Color fundus image — 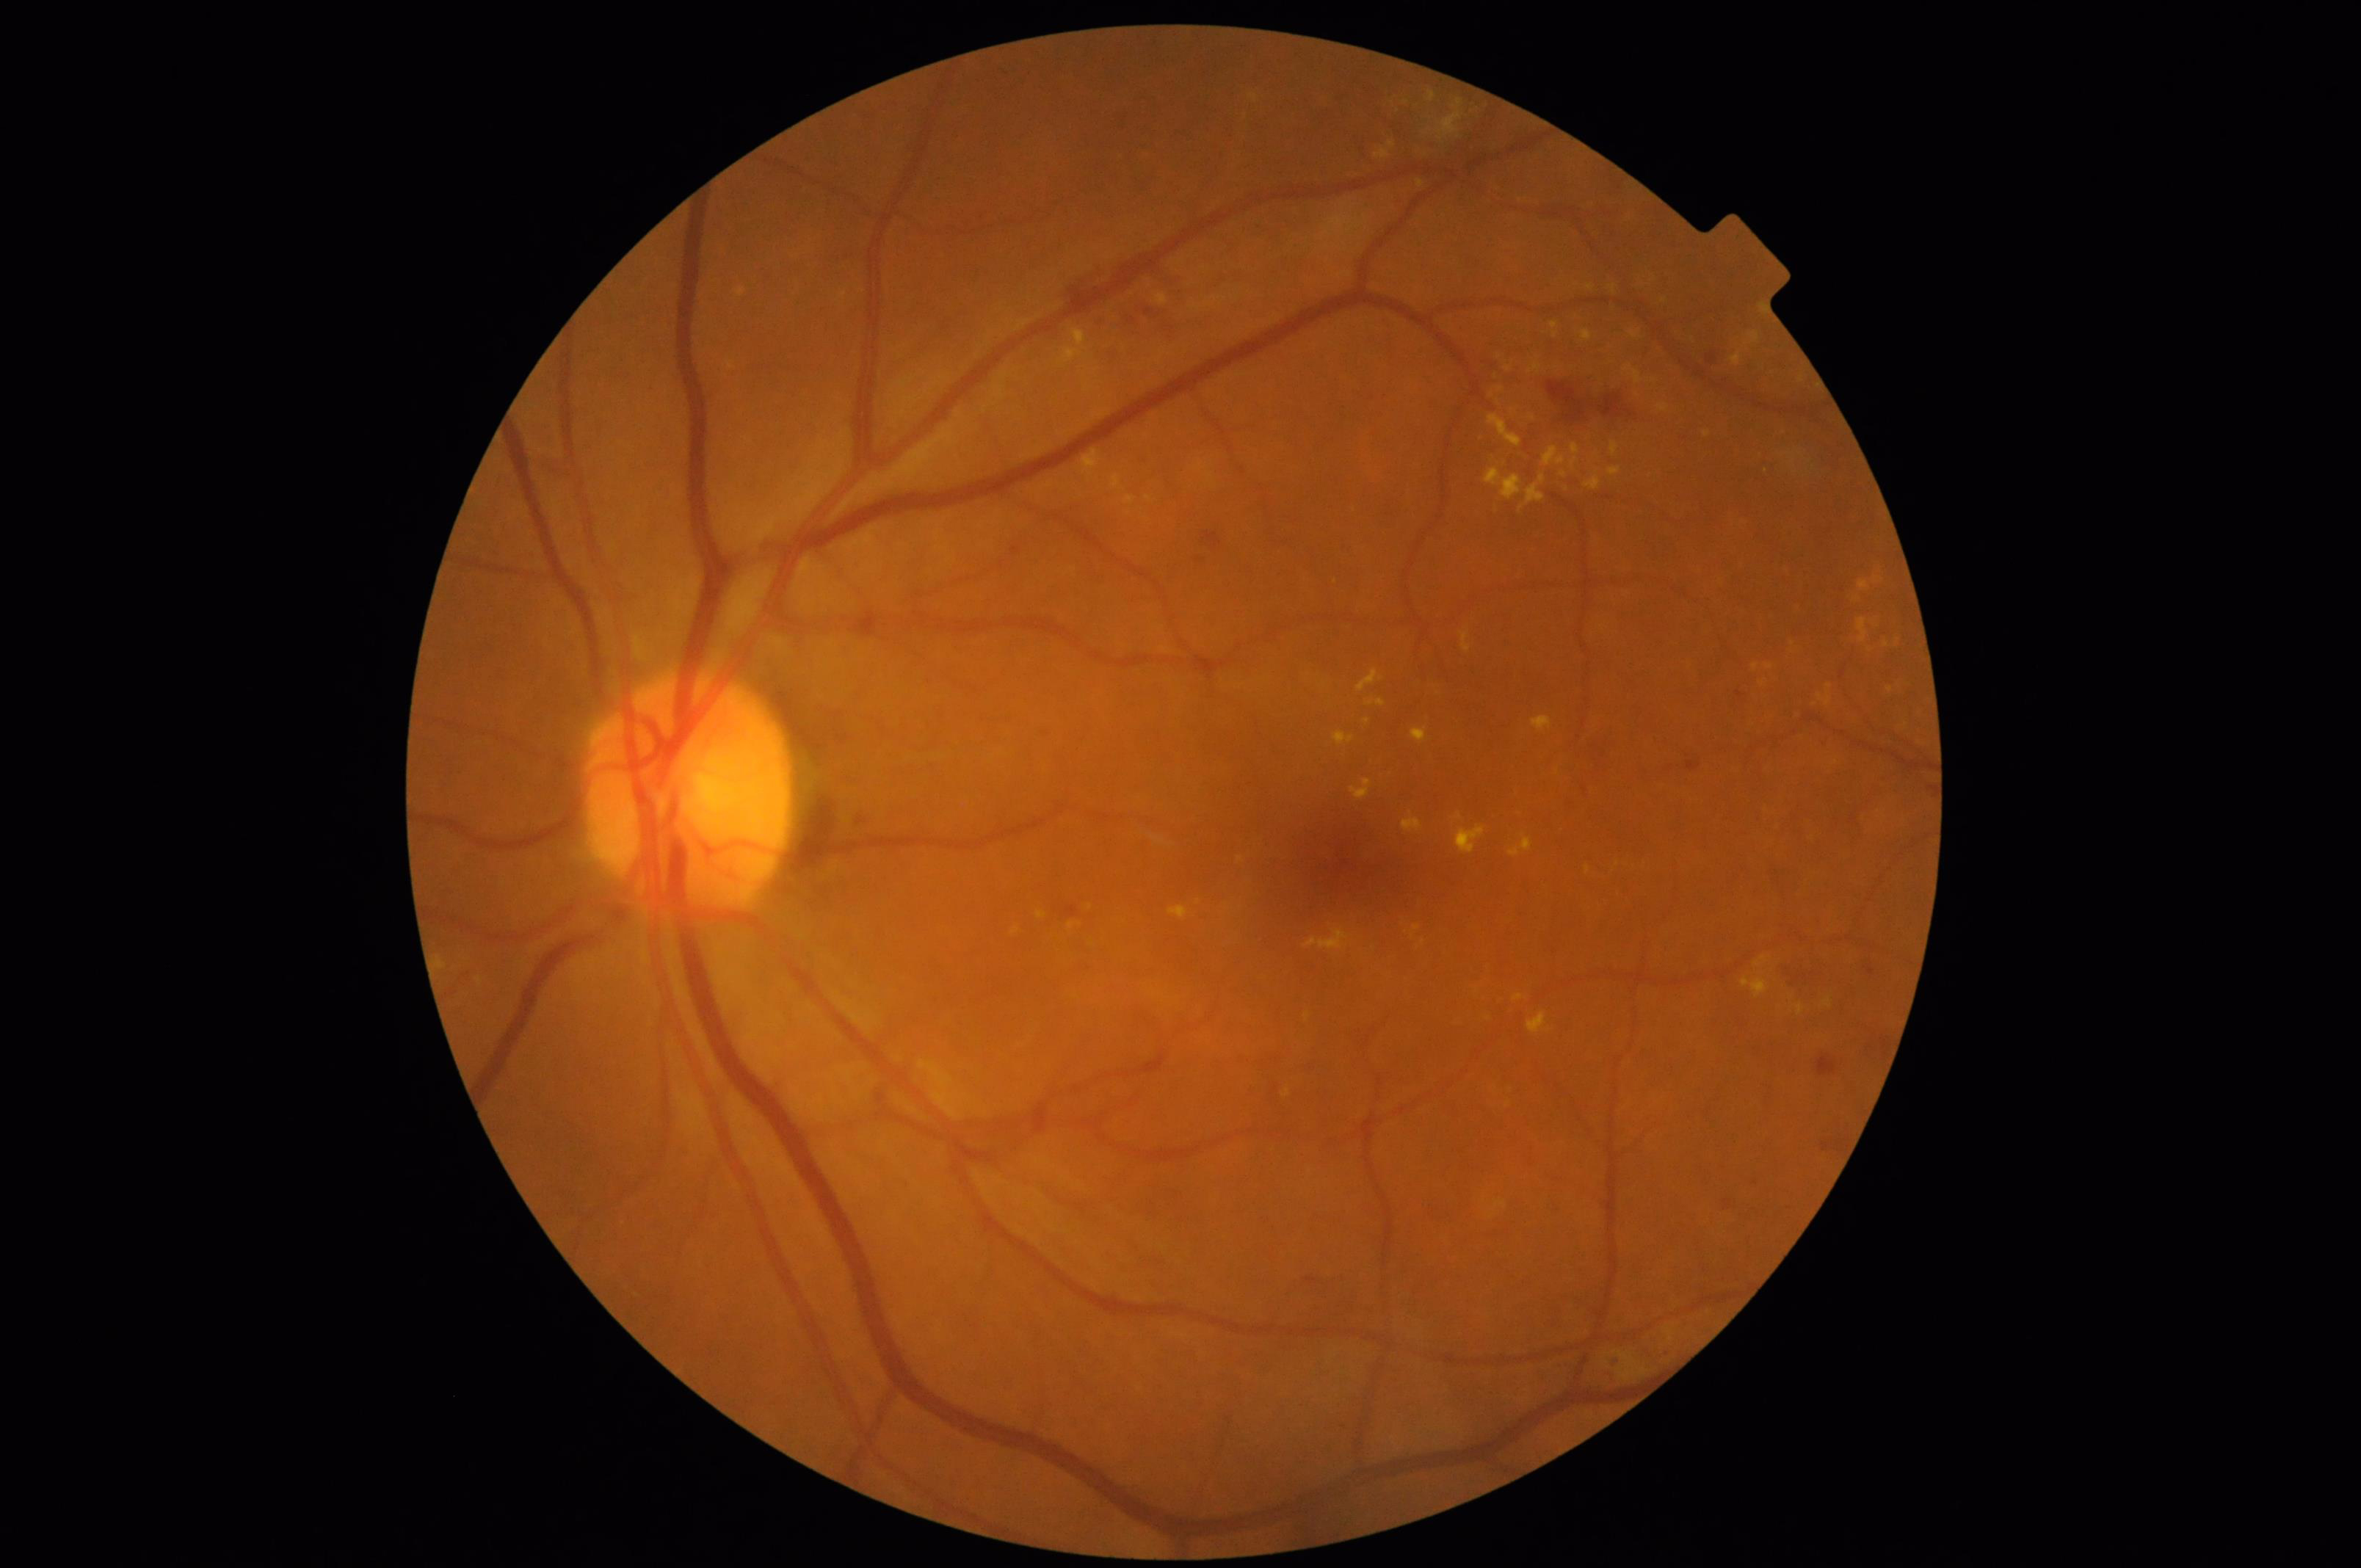 Illumination: good illumination and color balance | Overall quality: good and suitable for diagnostic use | Sharpness: sharp throughout the field | Contrast: vessels and details readily distinguishable.